1536x1152px · color fundus image — 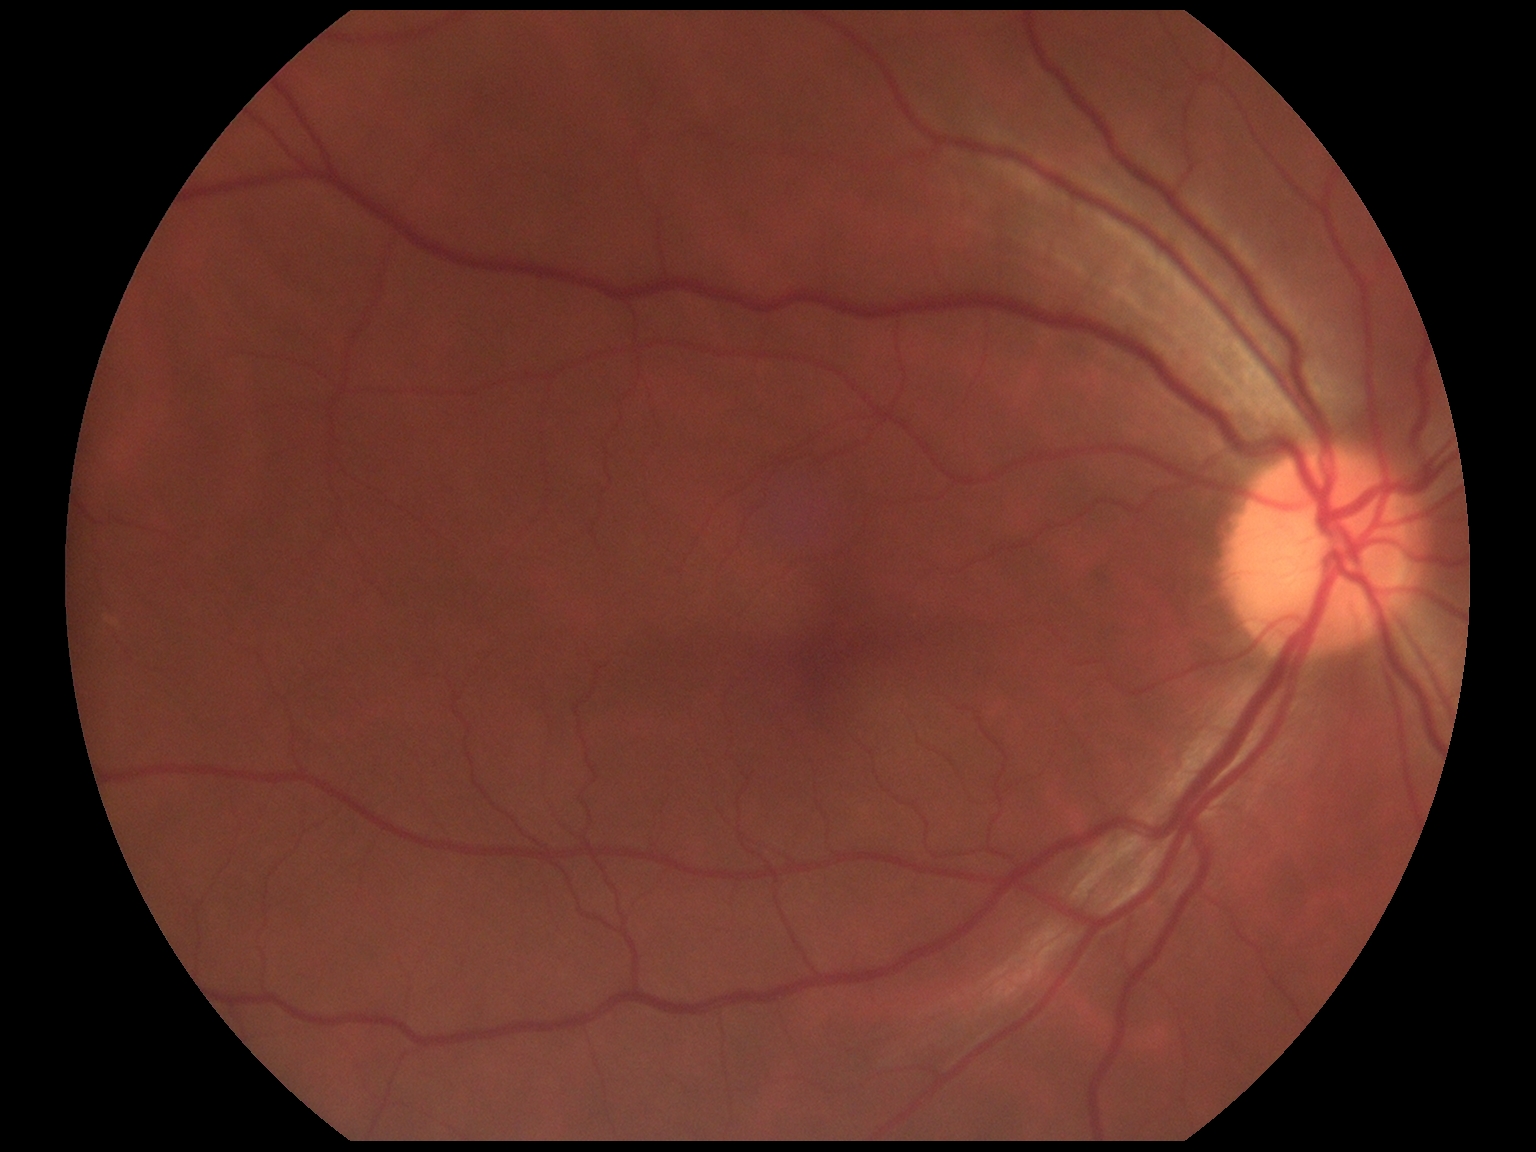   dr_grade: grade 0